2048 x 1536 pixels, 45-degree field of view:
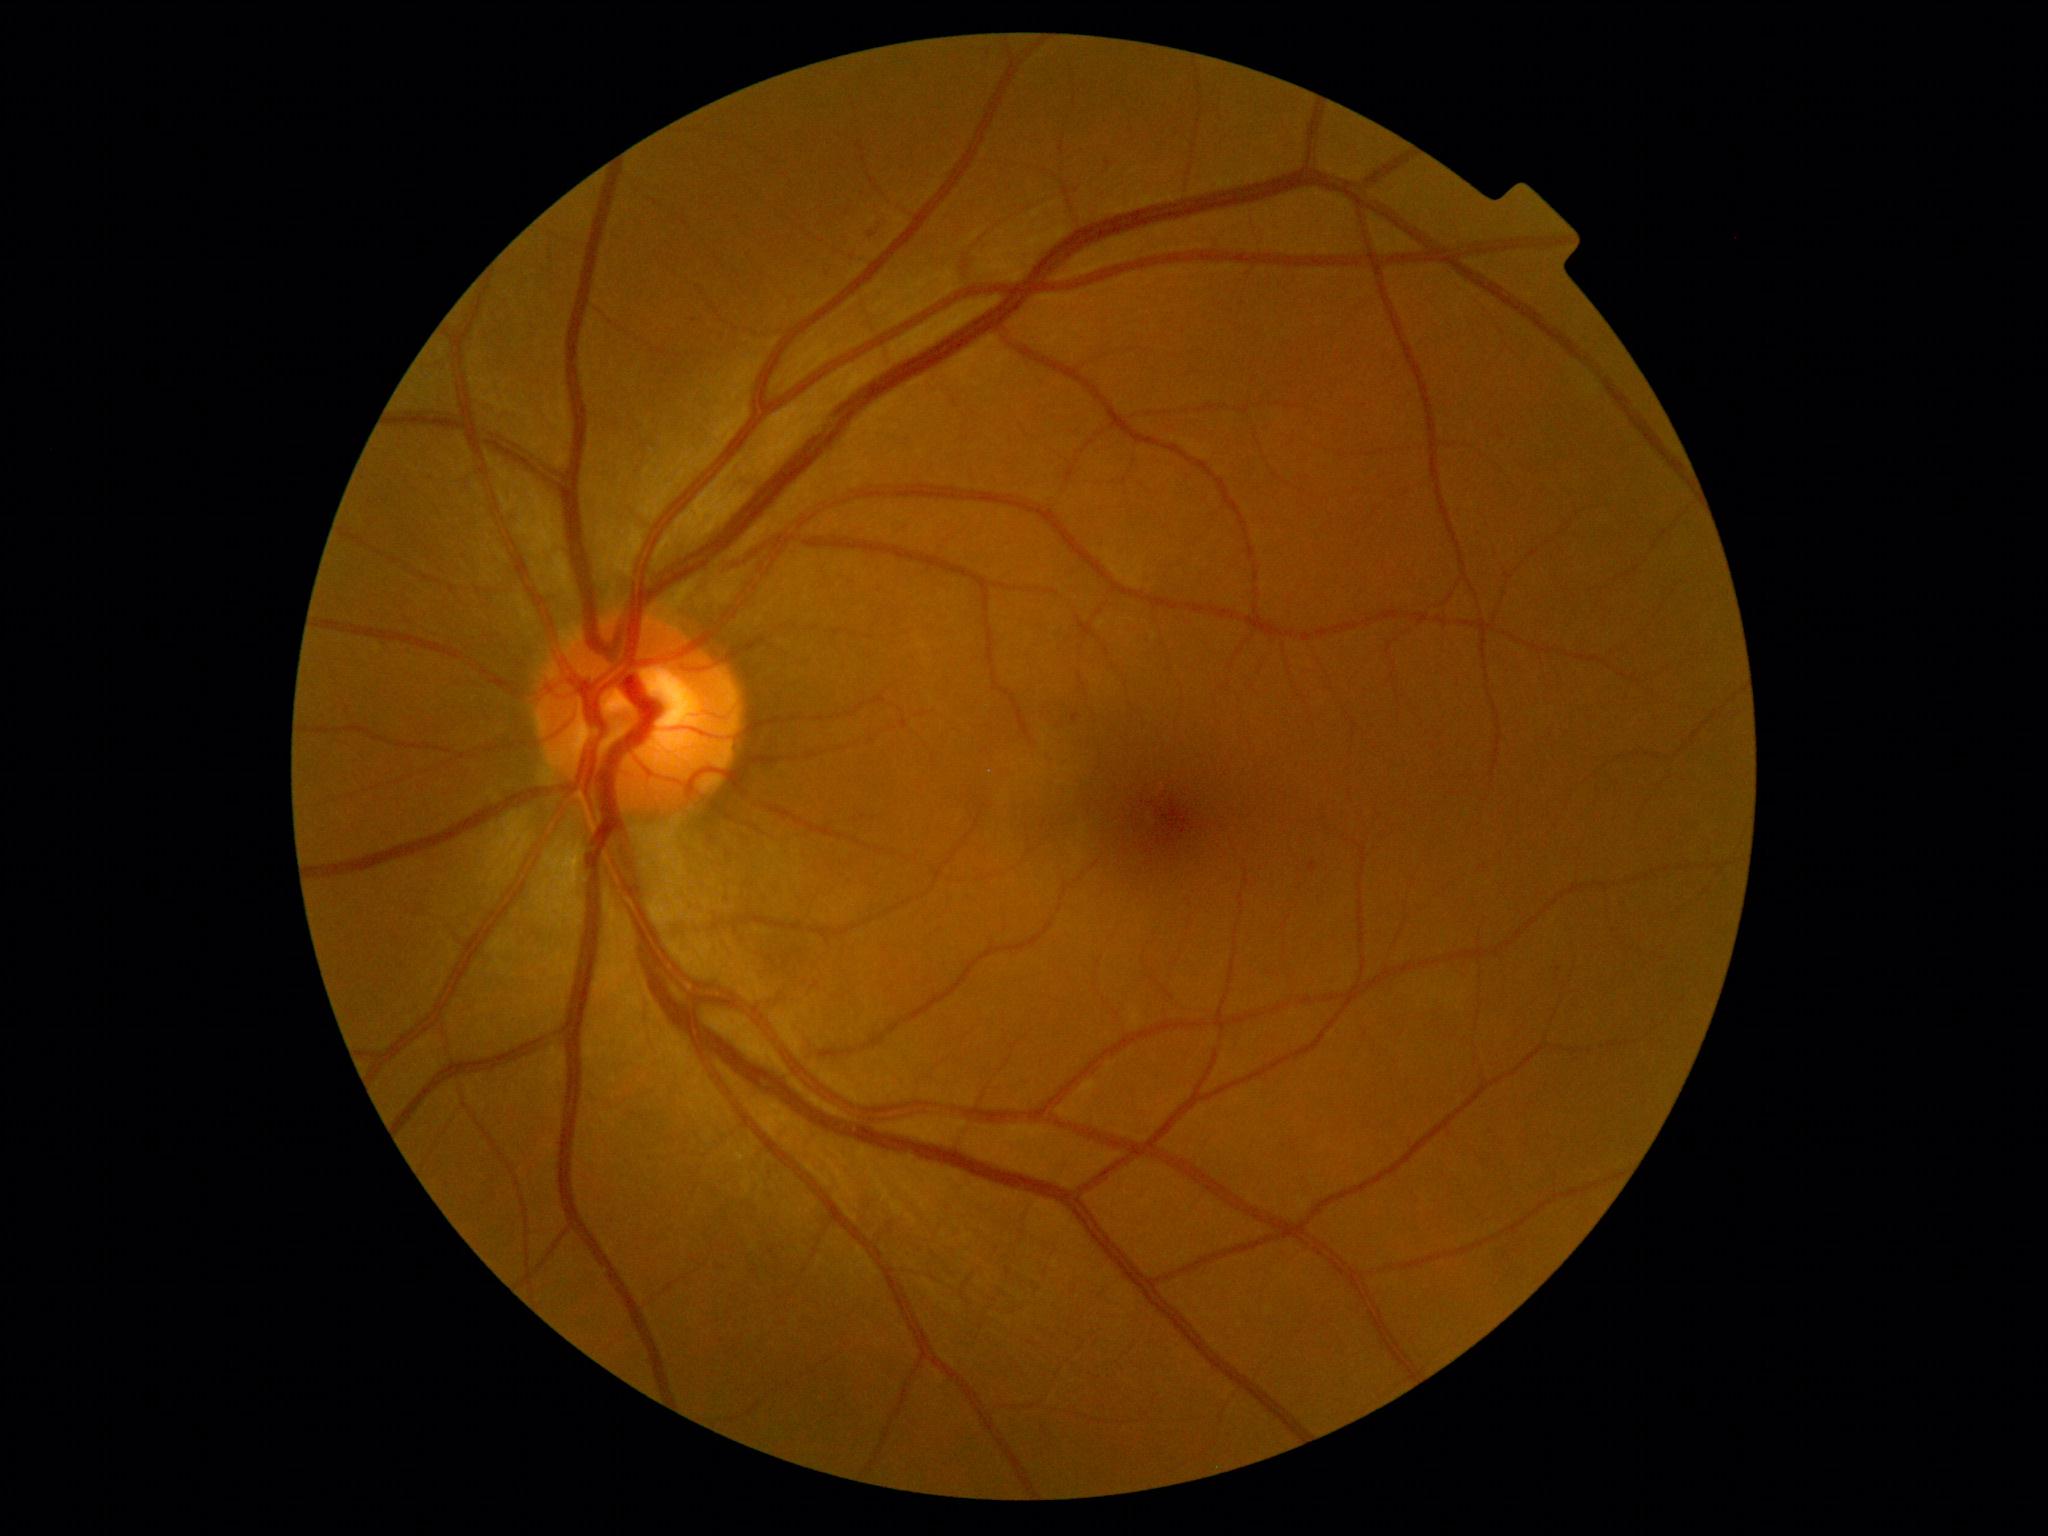   dr_grade: 1/4
  dr_category: non-proliferative diabetic retinopathy